CFP
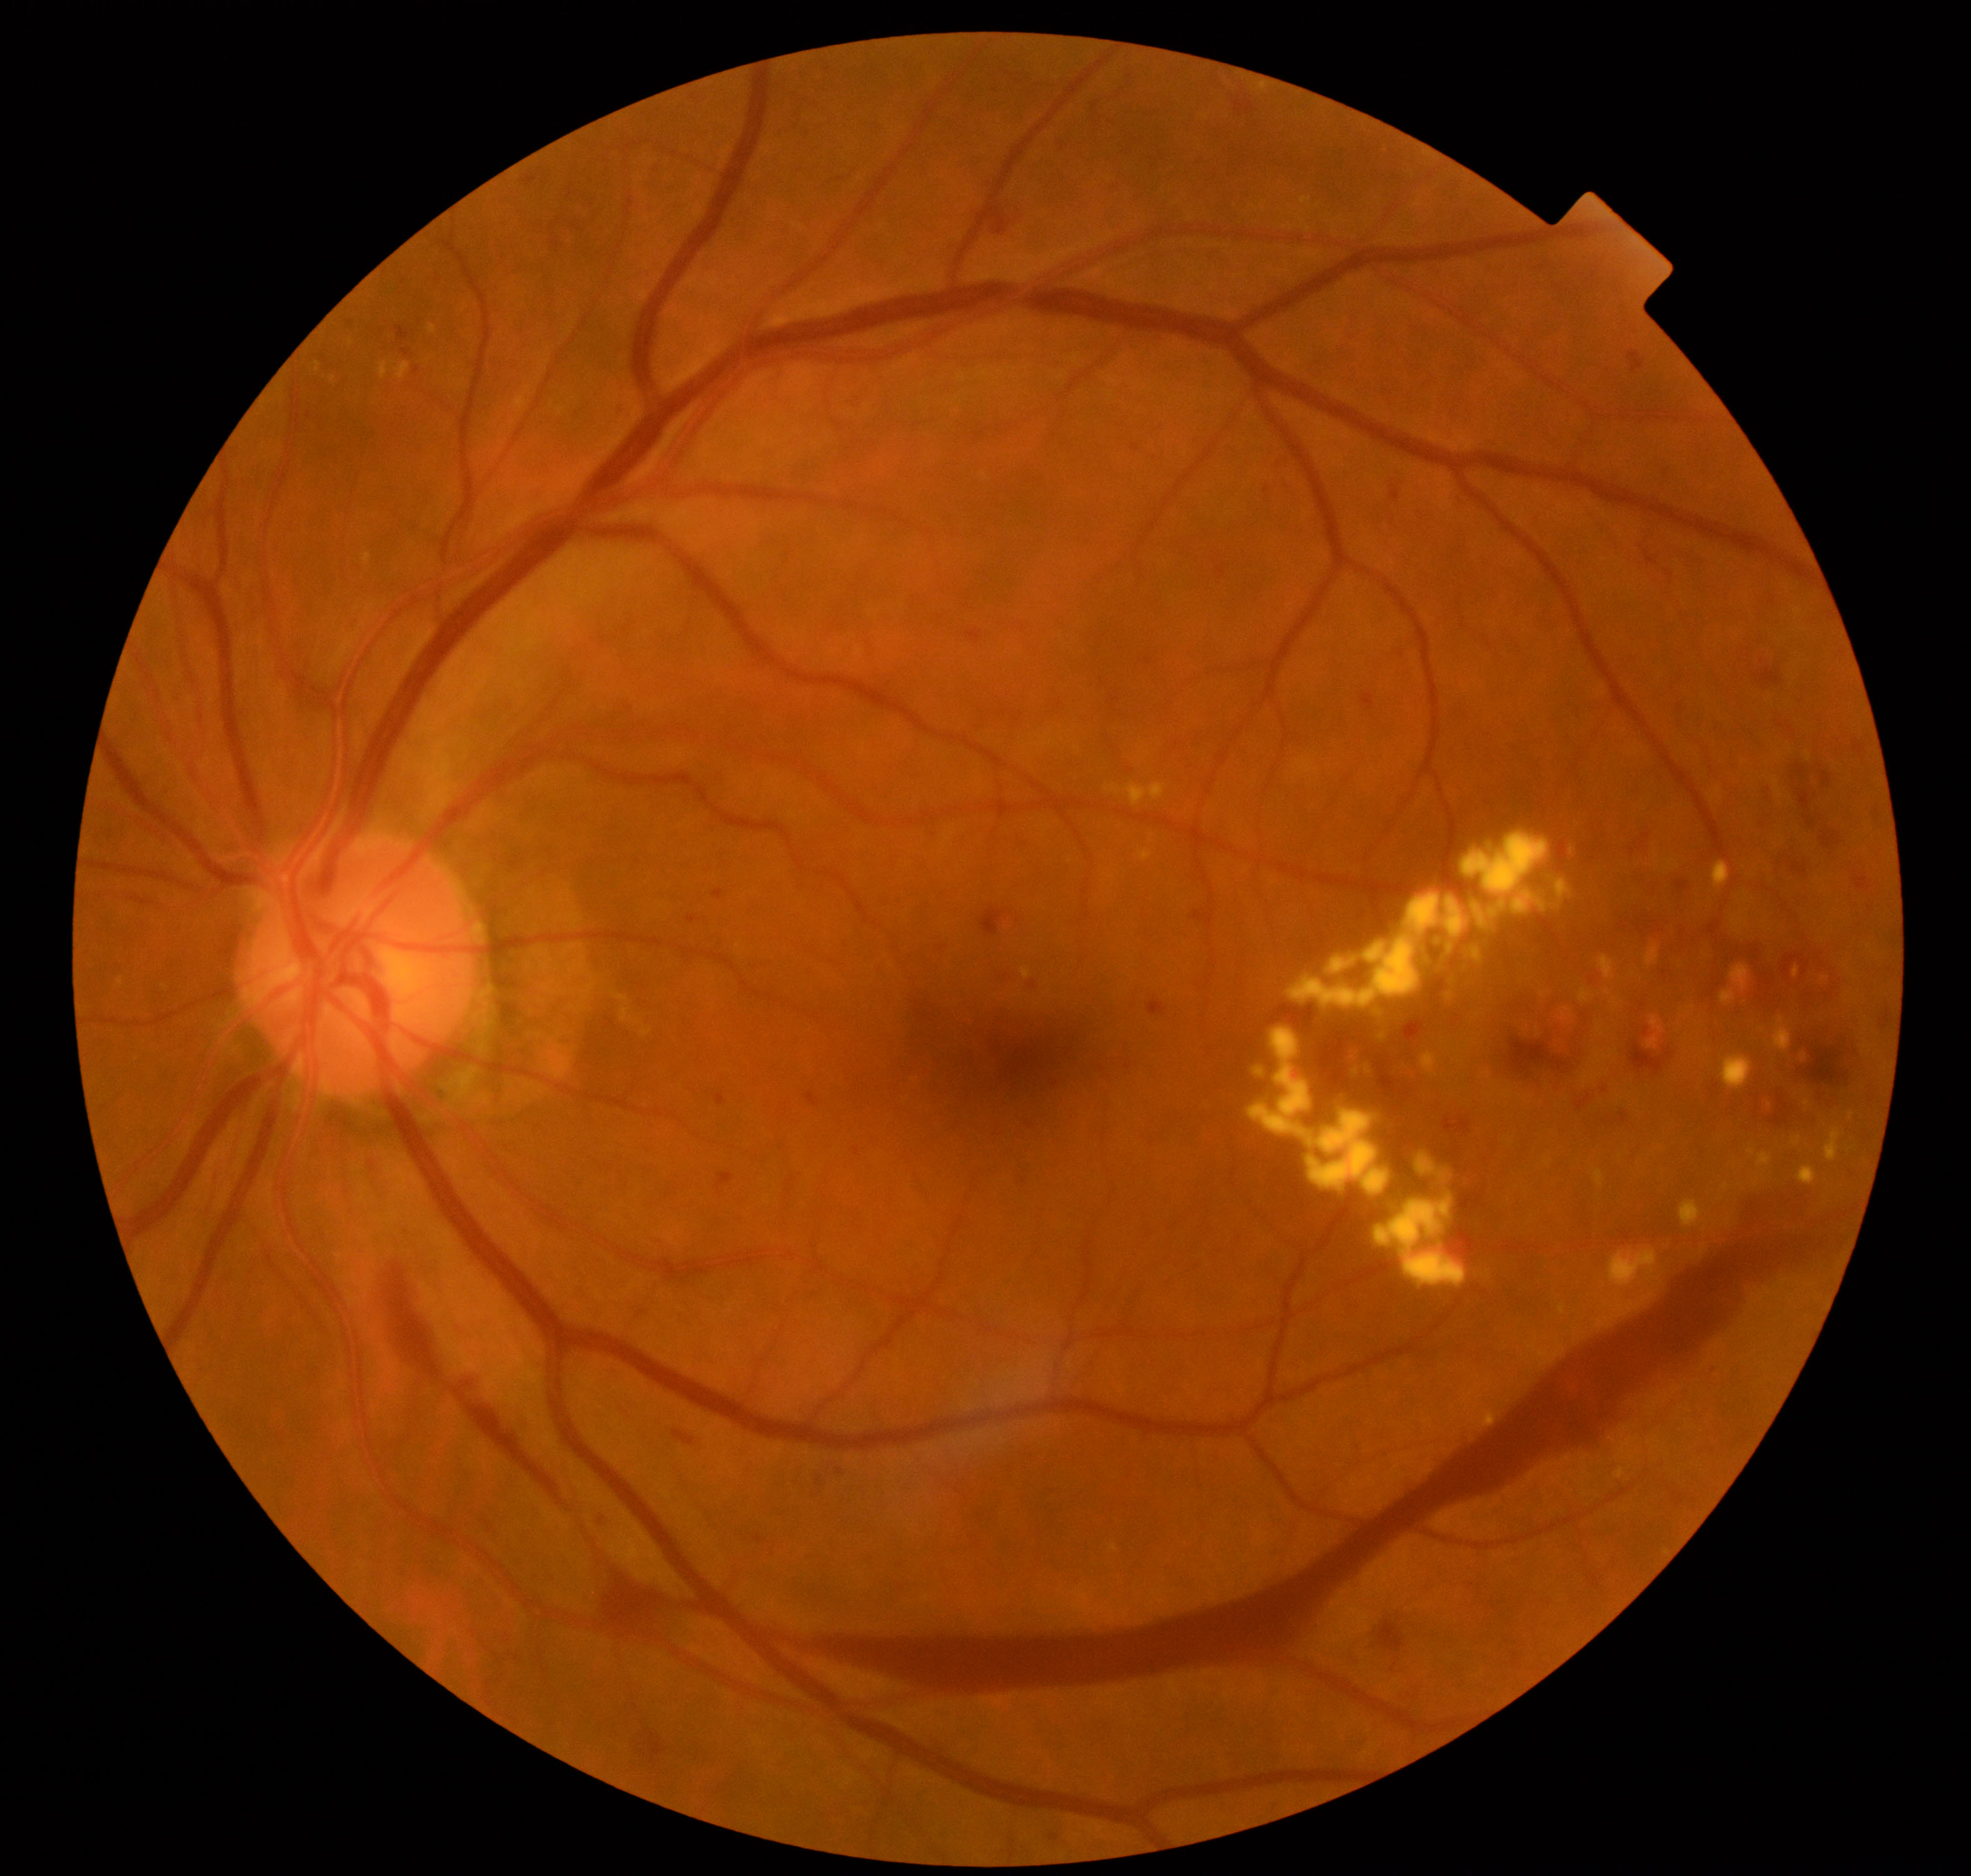 Findings consistent with severe non-proliferative or proliferative diabetic retinopathy.